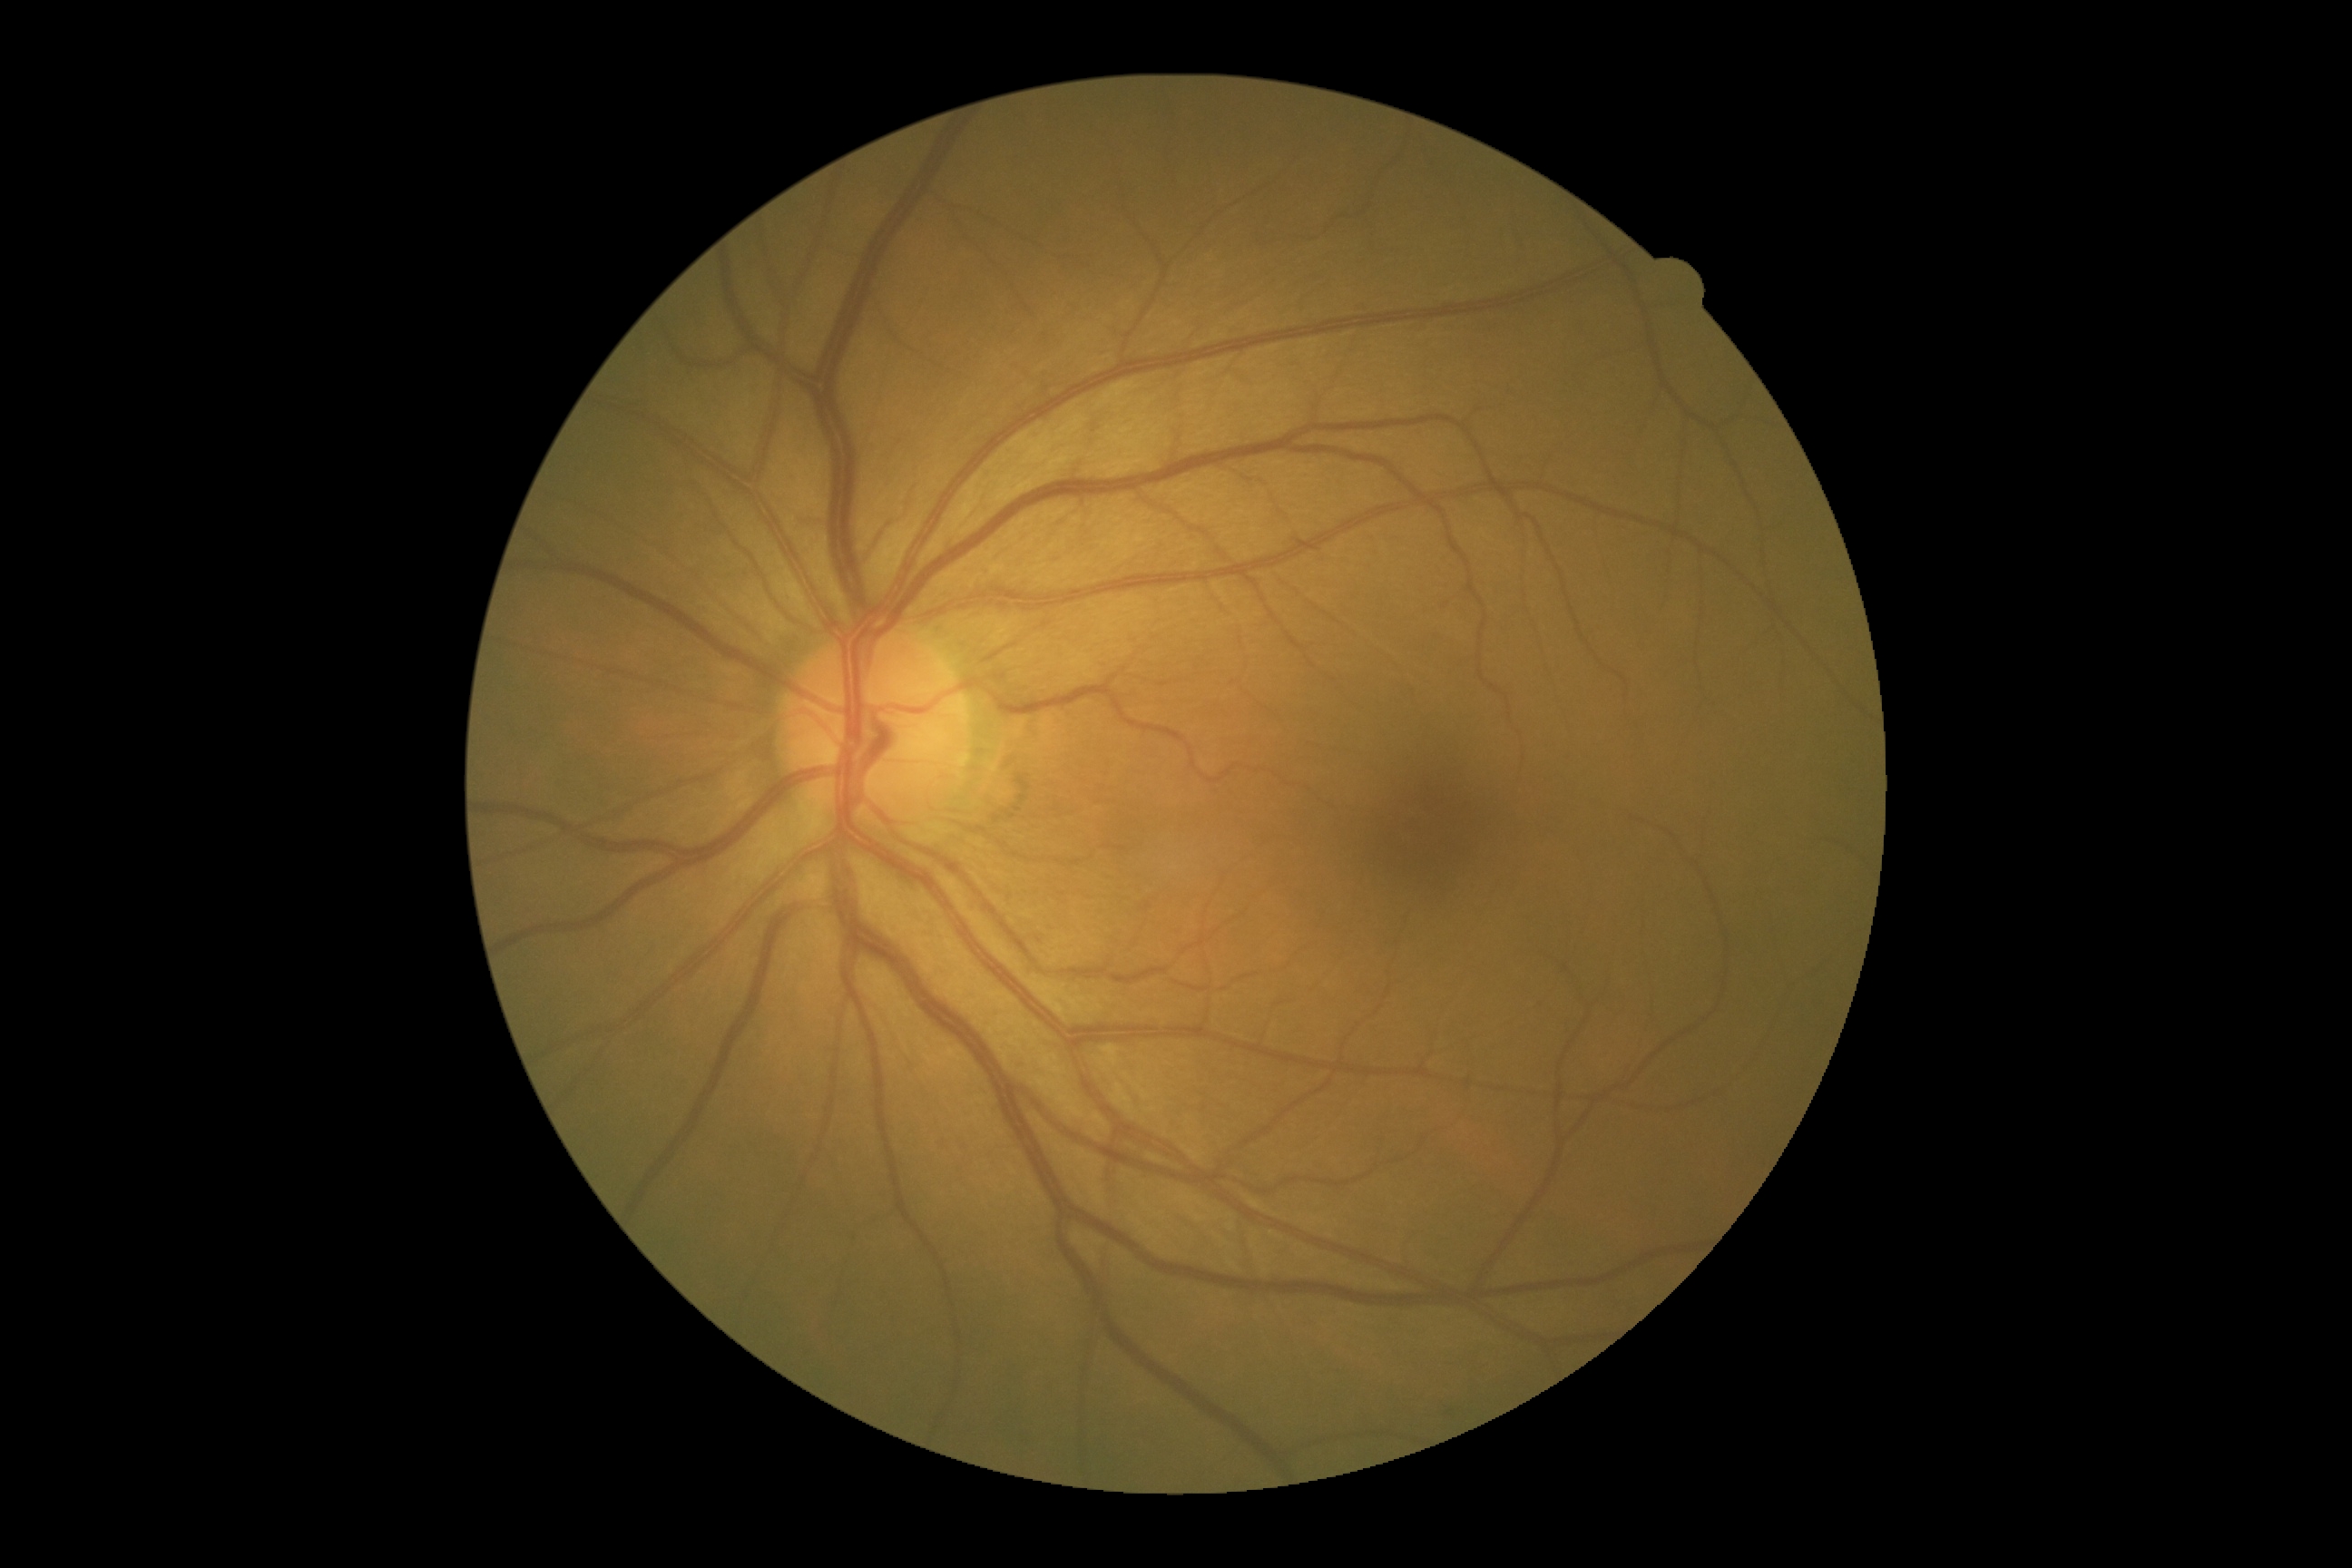
No signs of diabetic retinopathy.
DR grade is 0.